Phoenix ICON wide-field infant fundus image · image size 1240x1240 · captured with the Phoenix ICON (100° field of view) — 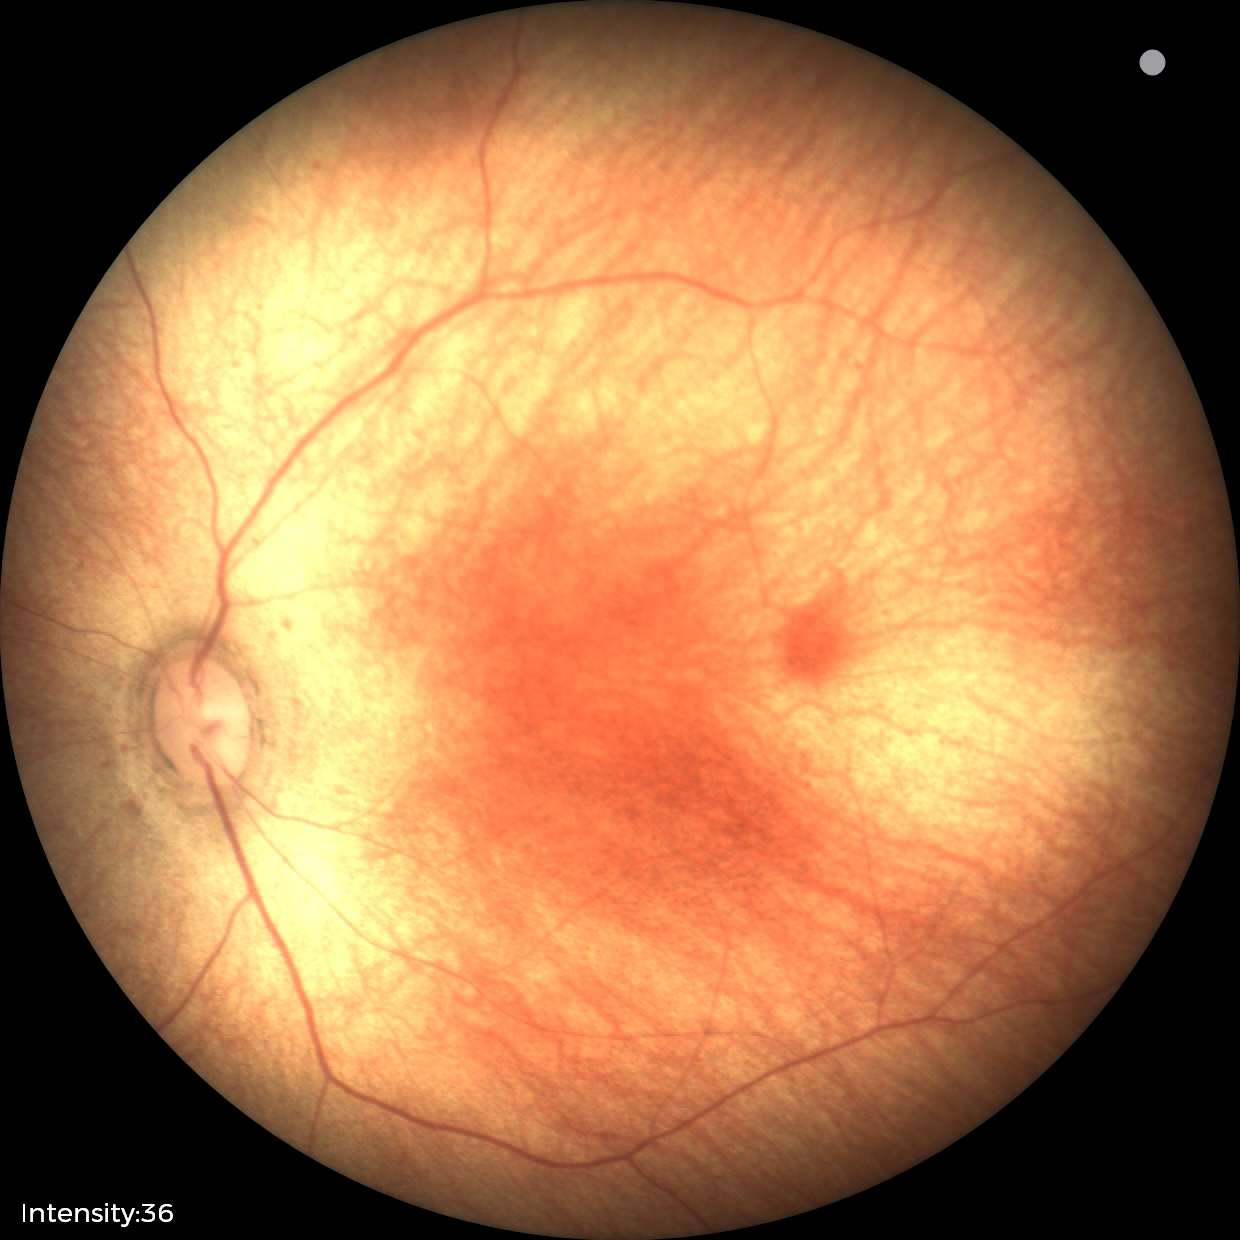 Physiological retinal appearance for postconceptual age.